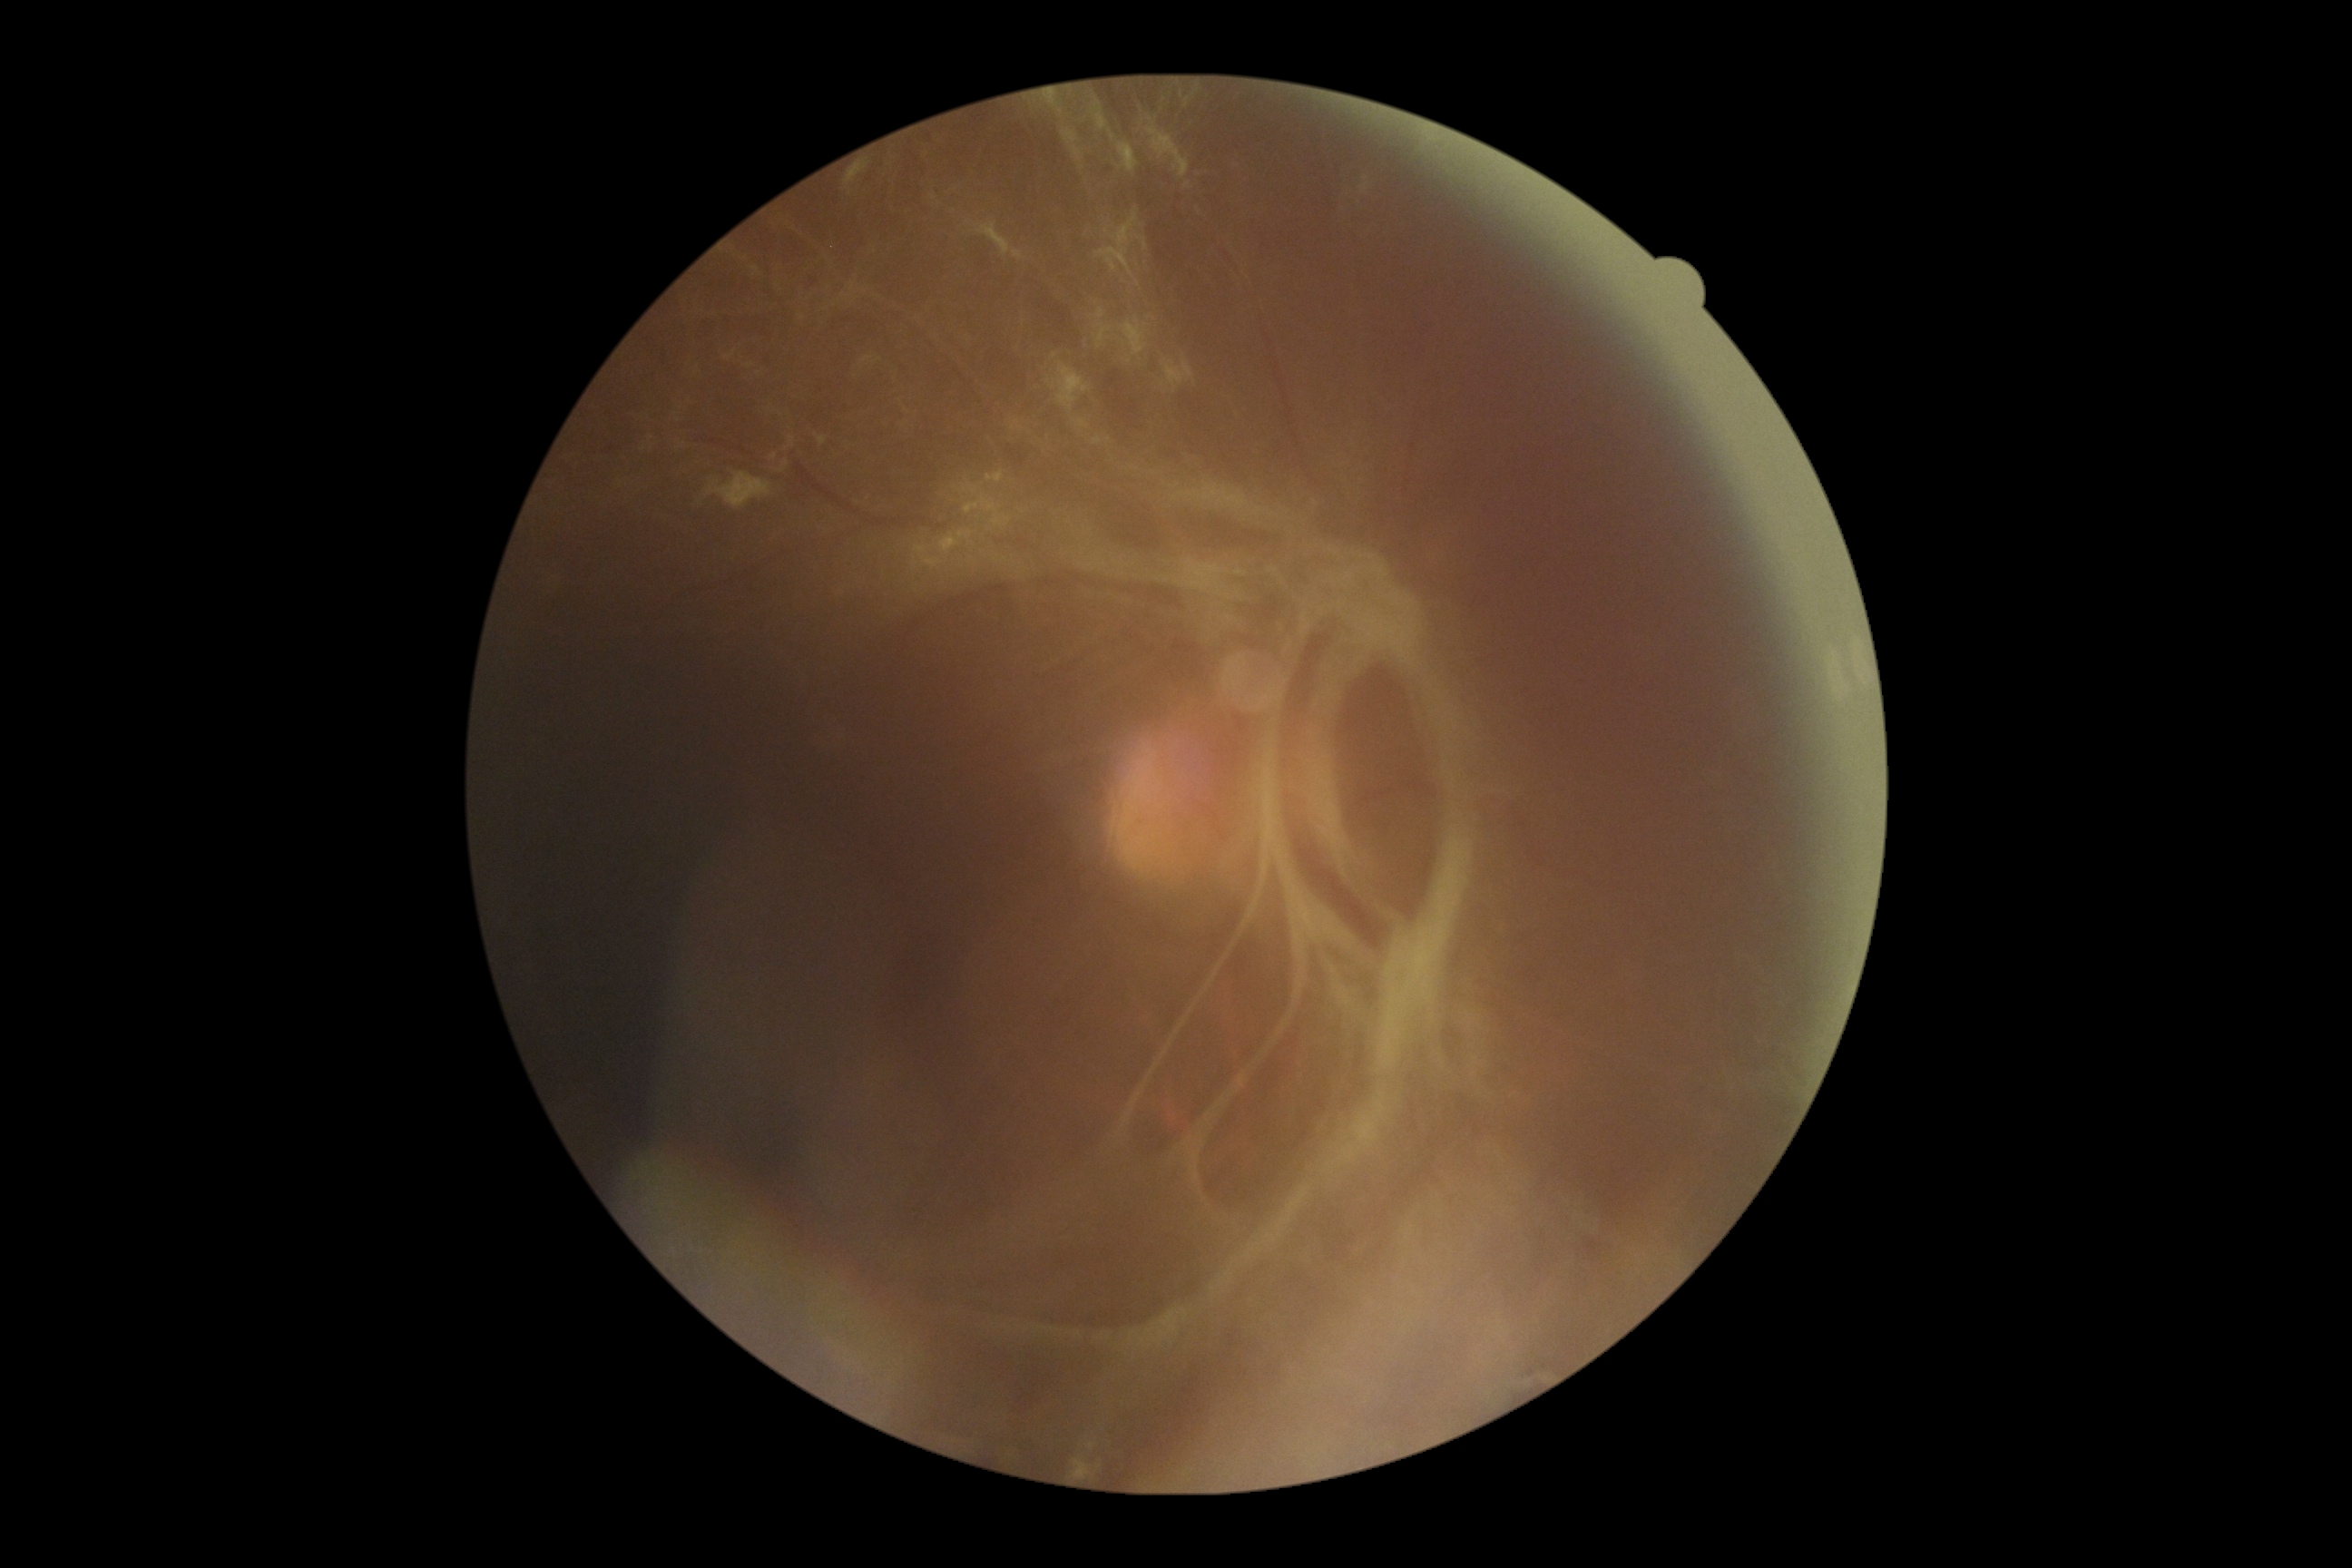
retinopathy grade=4.